Wide-field fundus image from infant ROP screening · captured with the Natus RetCam Envision (130° field of view).
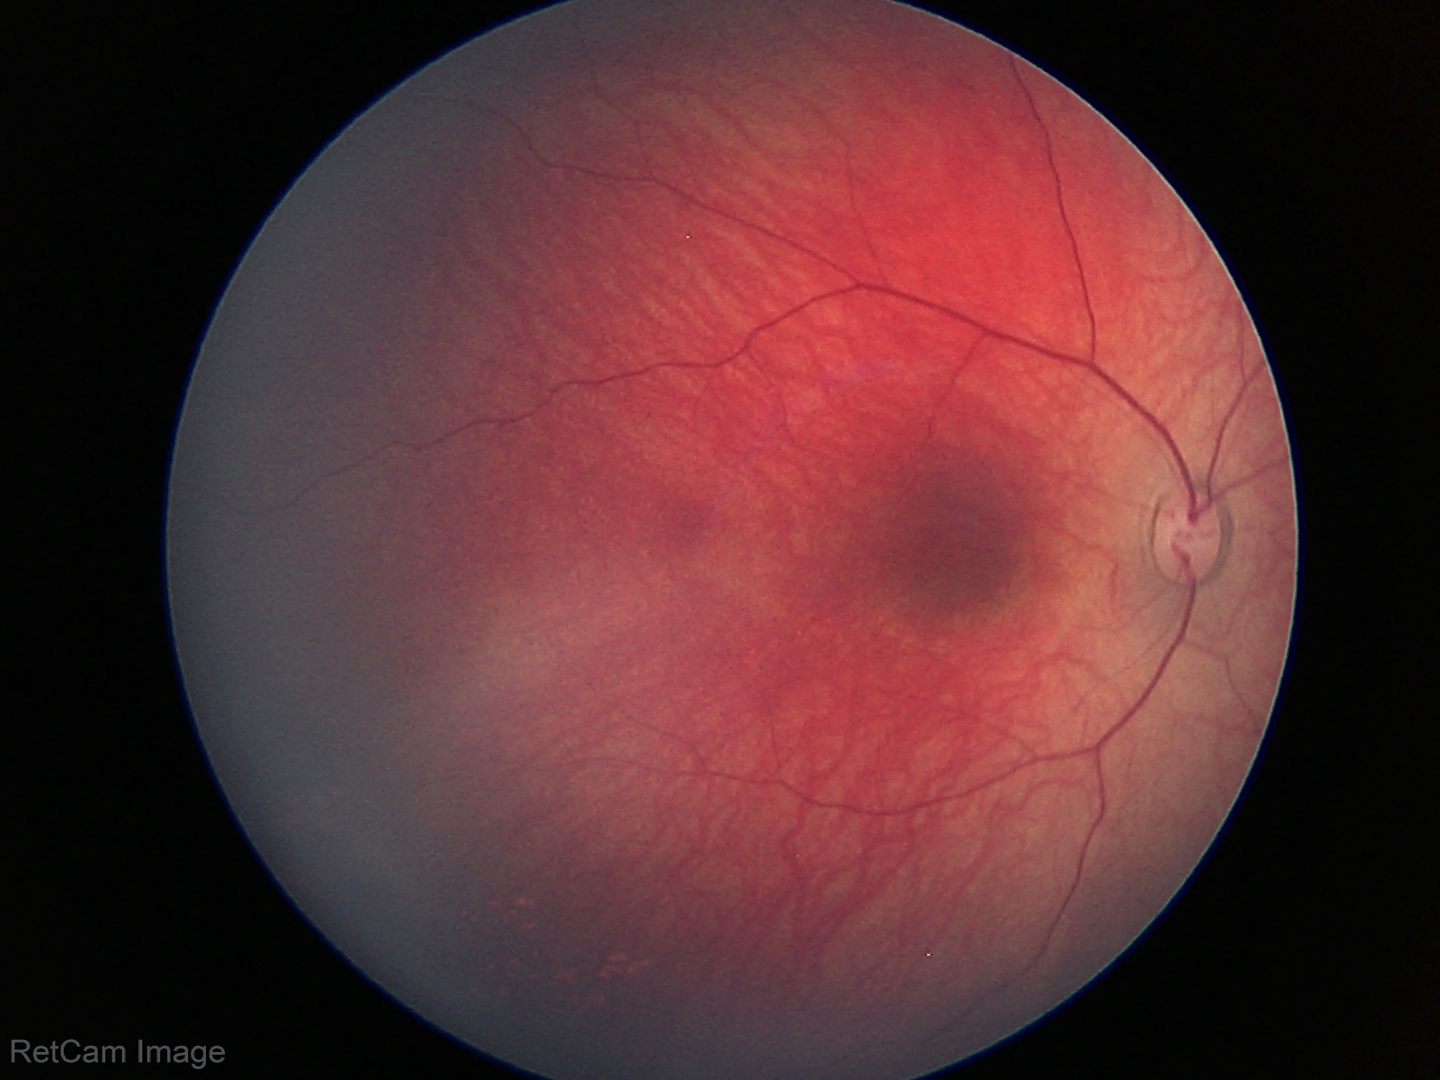 No retinal pathology identified on screening.